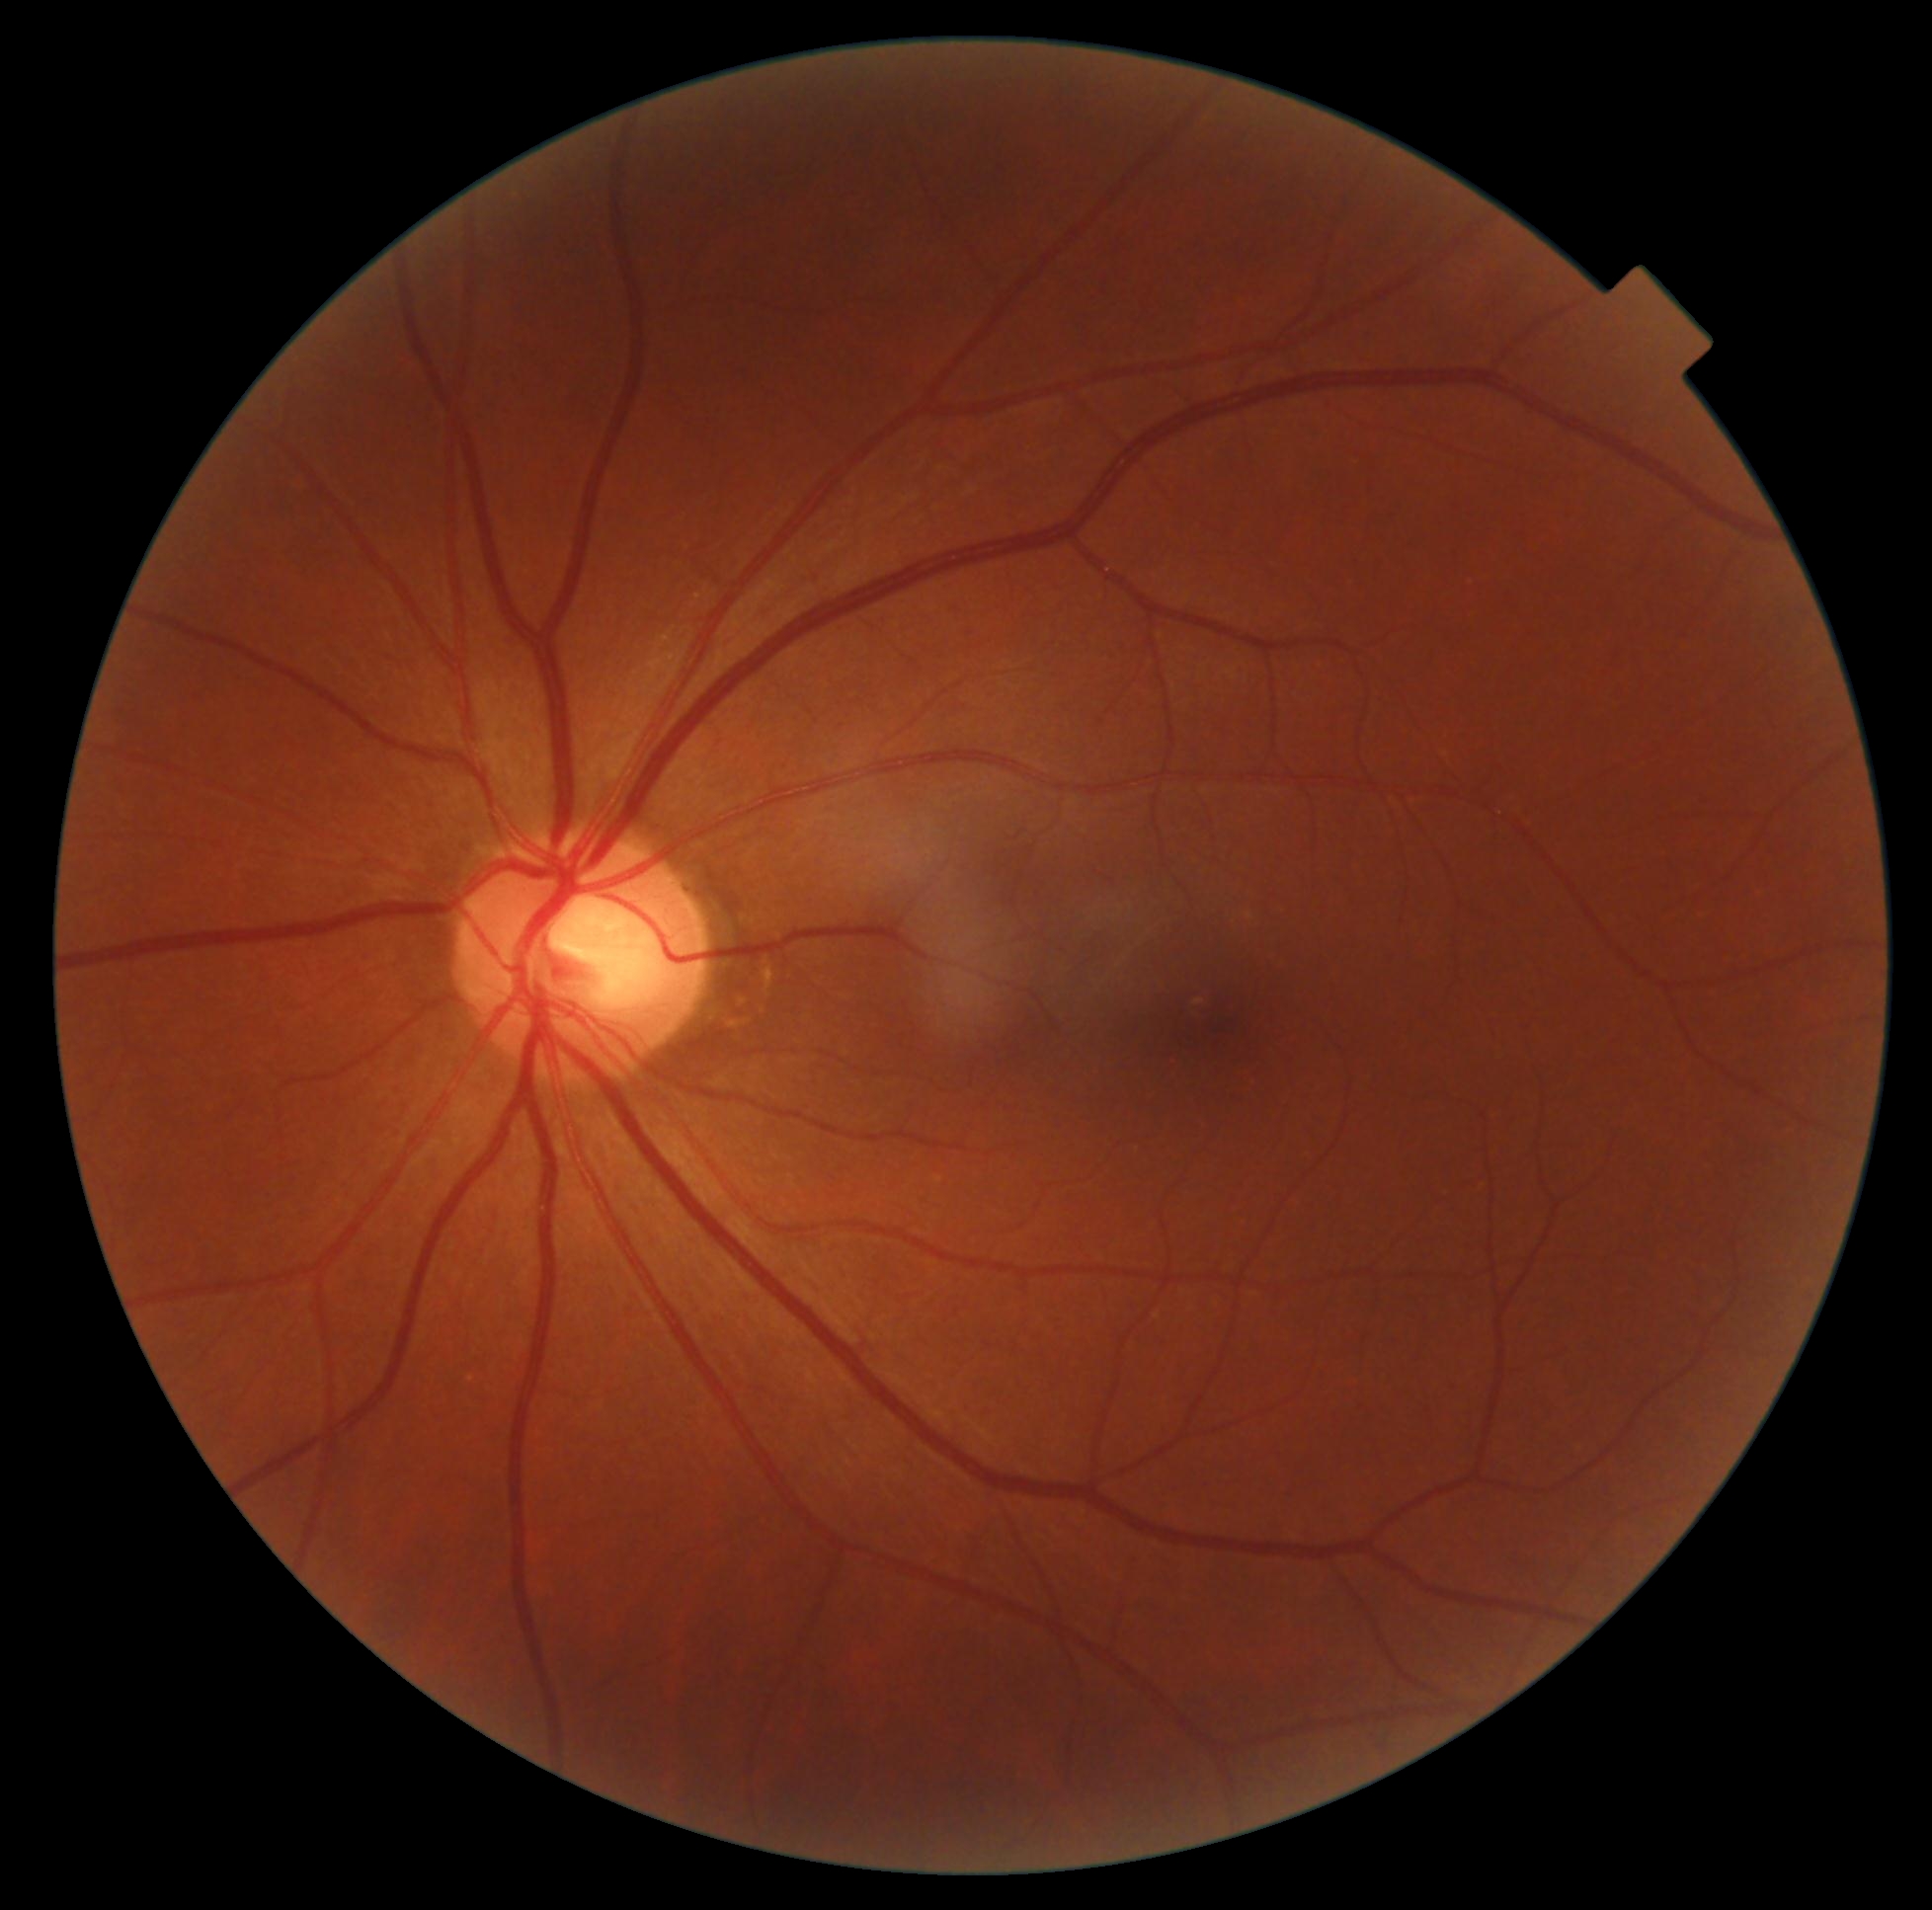
Retinopathy: grade 0.